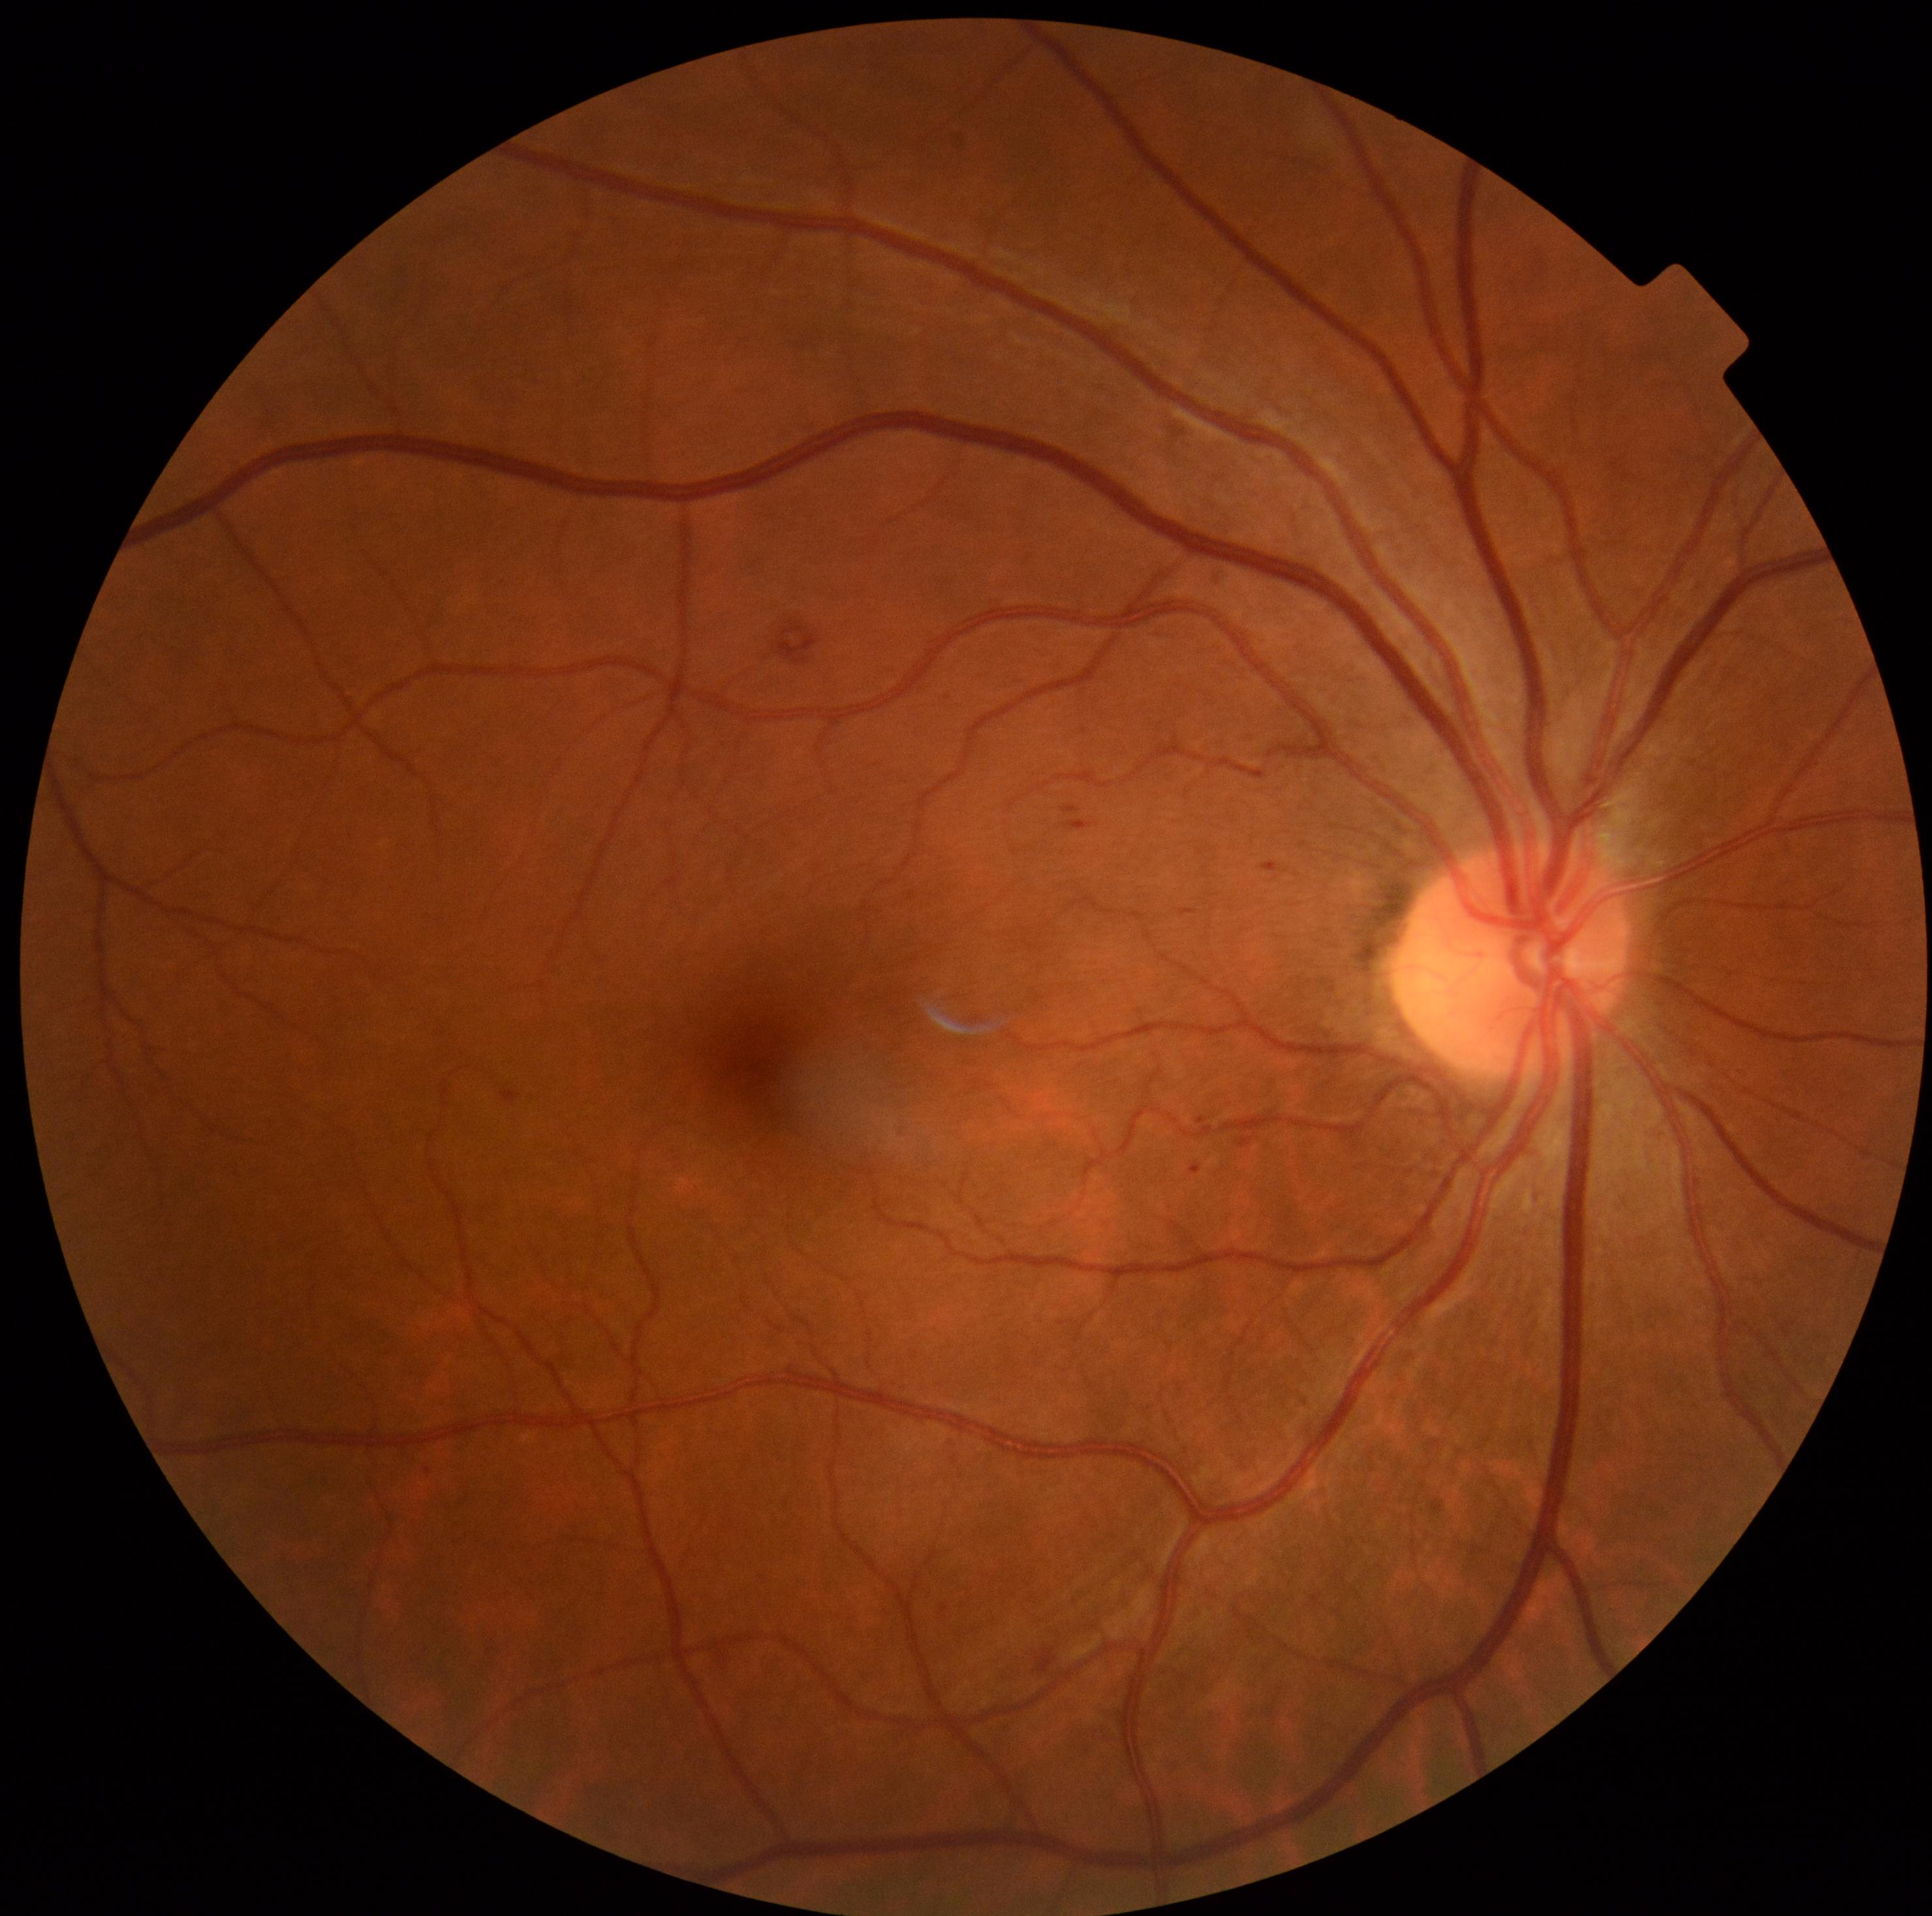
Diabetic retinopathy severity is moderate non-proliferative diabetic retinopathy (grade 2)
Detected lesions:
• hard exudates: none detected
• soft exudates: none detected
• microaneurysms: [left=502, top=1090, right=520, bottom=1105]; [left=1063, top=807, right=1082, bottom=815]; [left=1181, top=909, right=1198, bottom=917]; [left=1237, top=1137, right=1253, bottom=1148]; [left=1191, top=1163, right=1200, bottom=1174]; [left=1065, top=820, right=1098, bottom=832]; [left=1198, top=1116, right=1208, bottom=1124]; [left=1263, top=863, right=1281, bottom=872]
• Small microaneurysms approximately at {"x": 948, "y": 698}
• hemorrhages: [left=1037, top=1649, right=1057, bottom=1674]; [left=776, top=623, right=818, bottom=665]